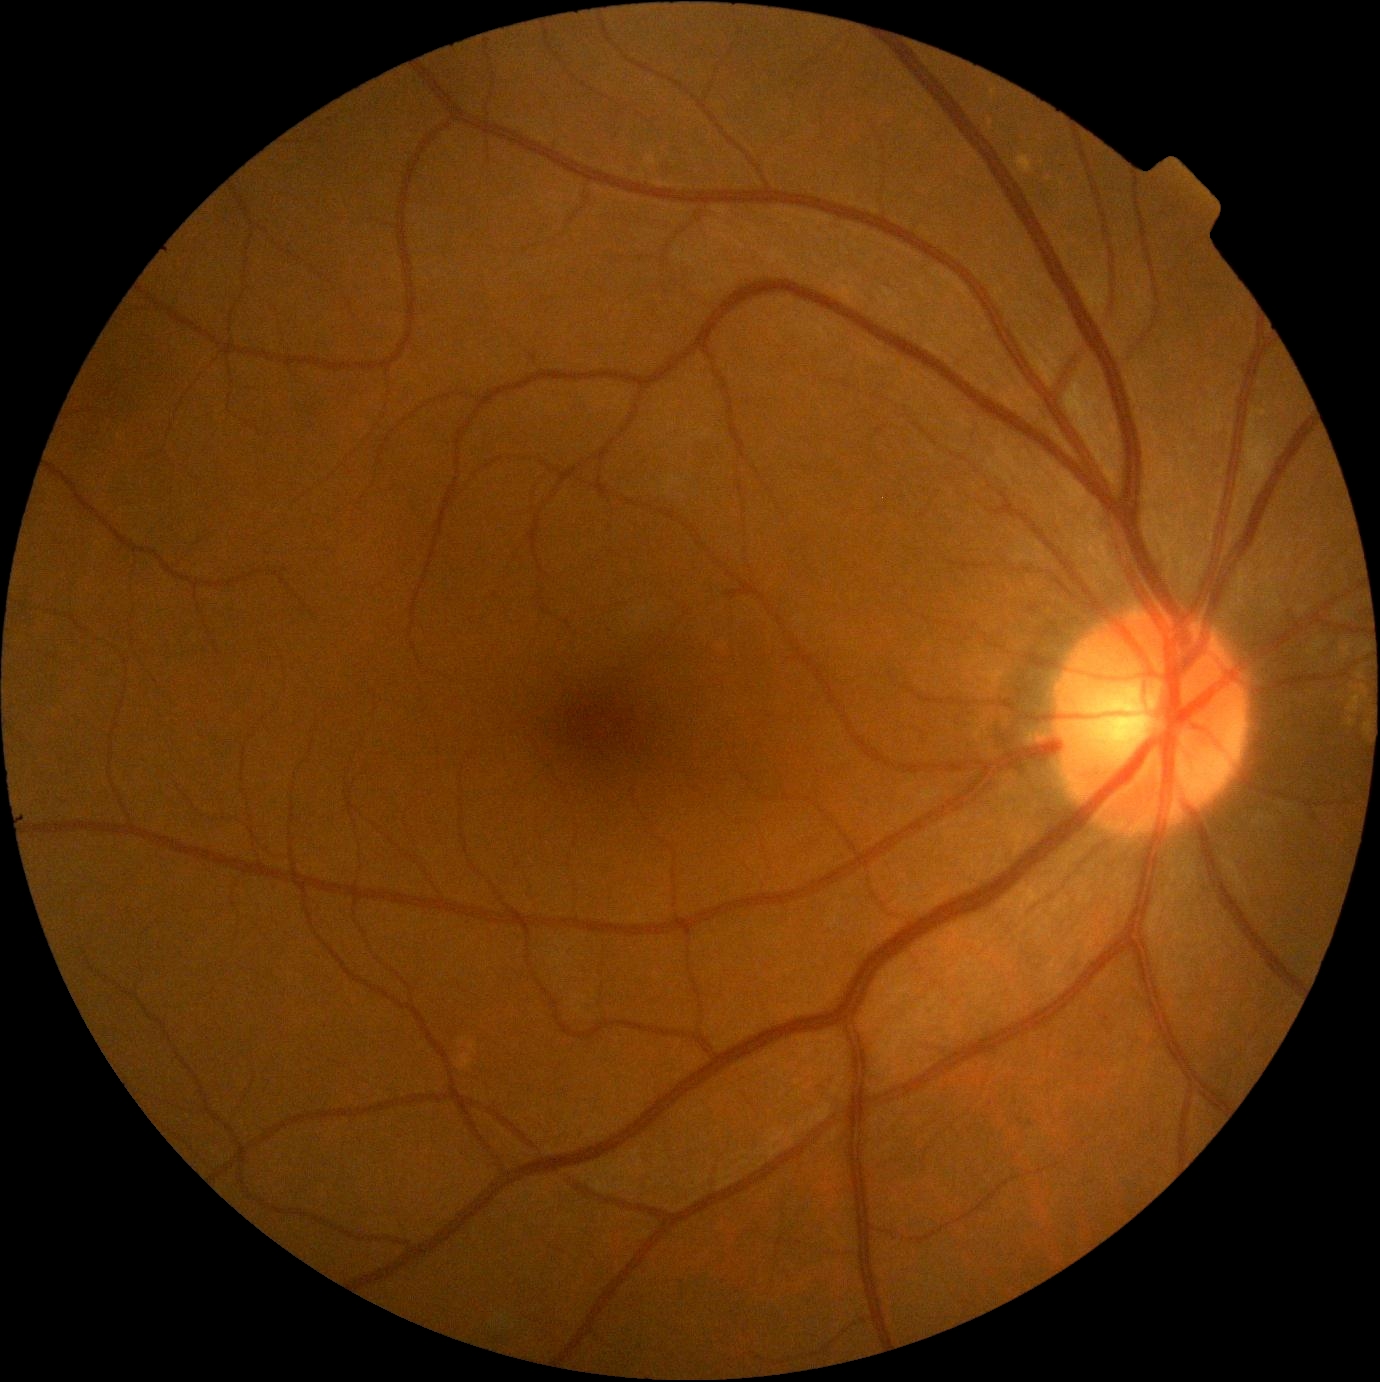

Diabetic retinopathy (DR): no apparent diabetic retinopathy (grade 0).